Pediatric wide-field fundus photograph; 130° field of view (Clarity RetCam 3): 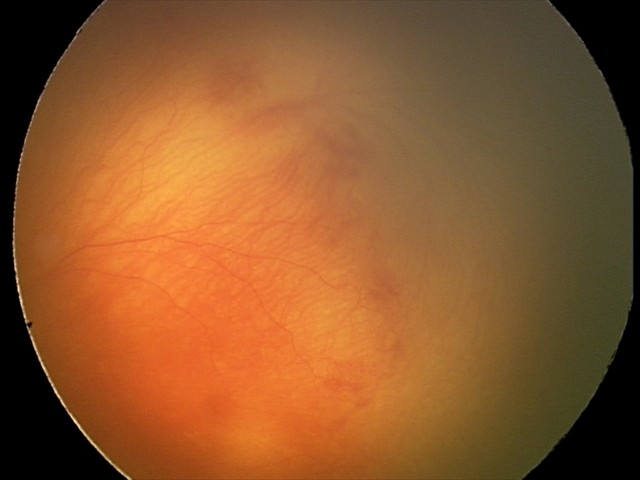 With plus disease.
Series diagnosed as aggressive retinopathy of prematurity (A-ROP) — rapidly progressive severe ROP with prominent plus disease, often without classic stage progression.